45° FOV, retinal fundus photograph, 1380x1382:
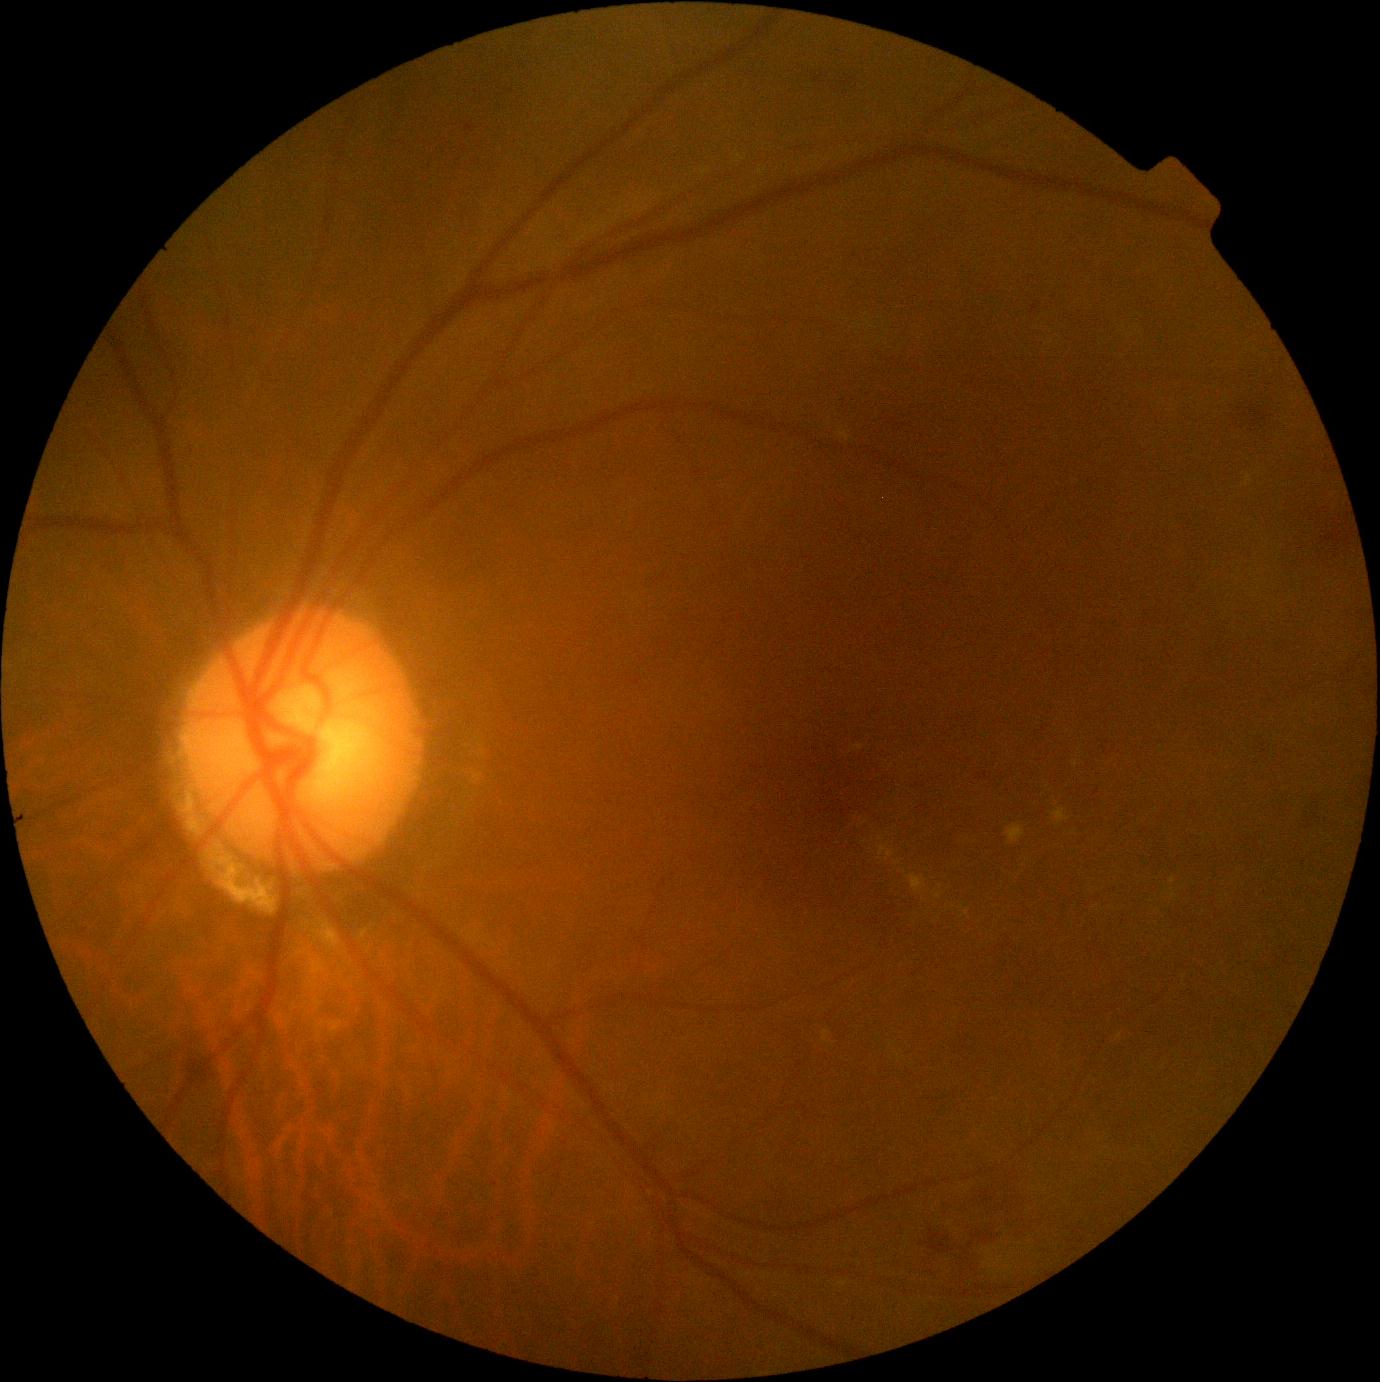 The retinopathy is classified as non-proliferative diabetic retinopathy.
Retinopathy is 2/4.